100° field of view (Phoenix ICON) · infant wide-field retinal image: 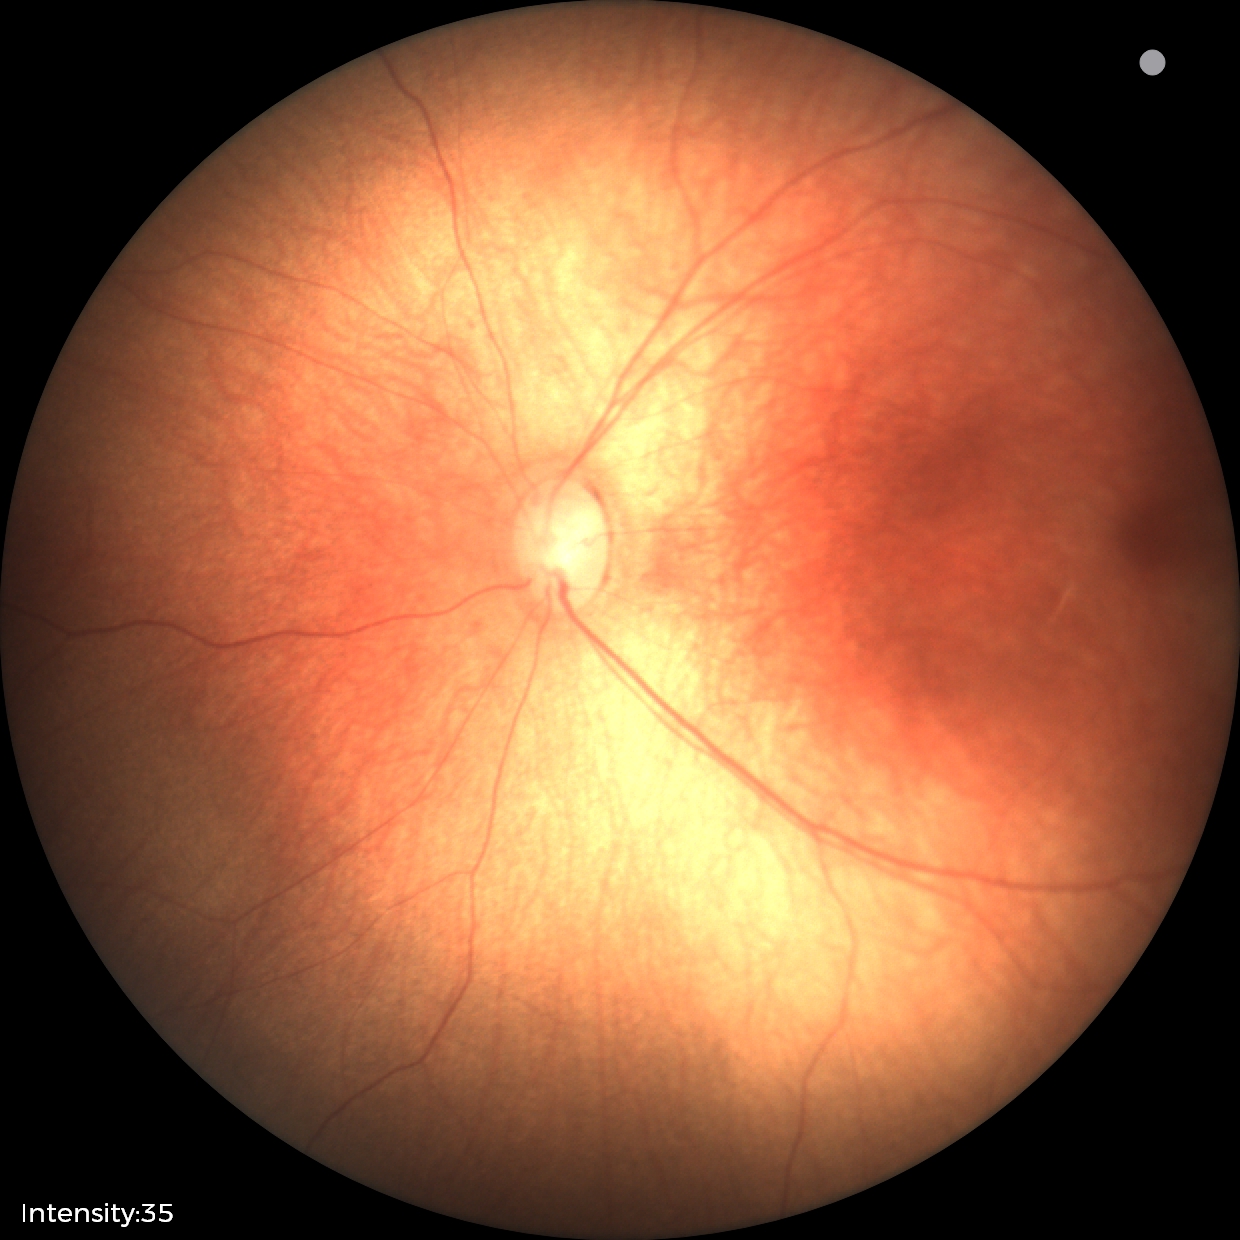

Diagnosis: normal retinal appearance